2352x1568px; fundus photo — 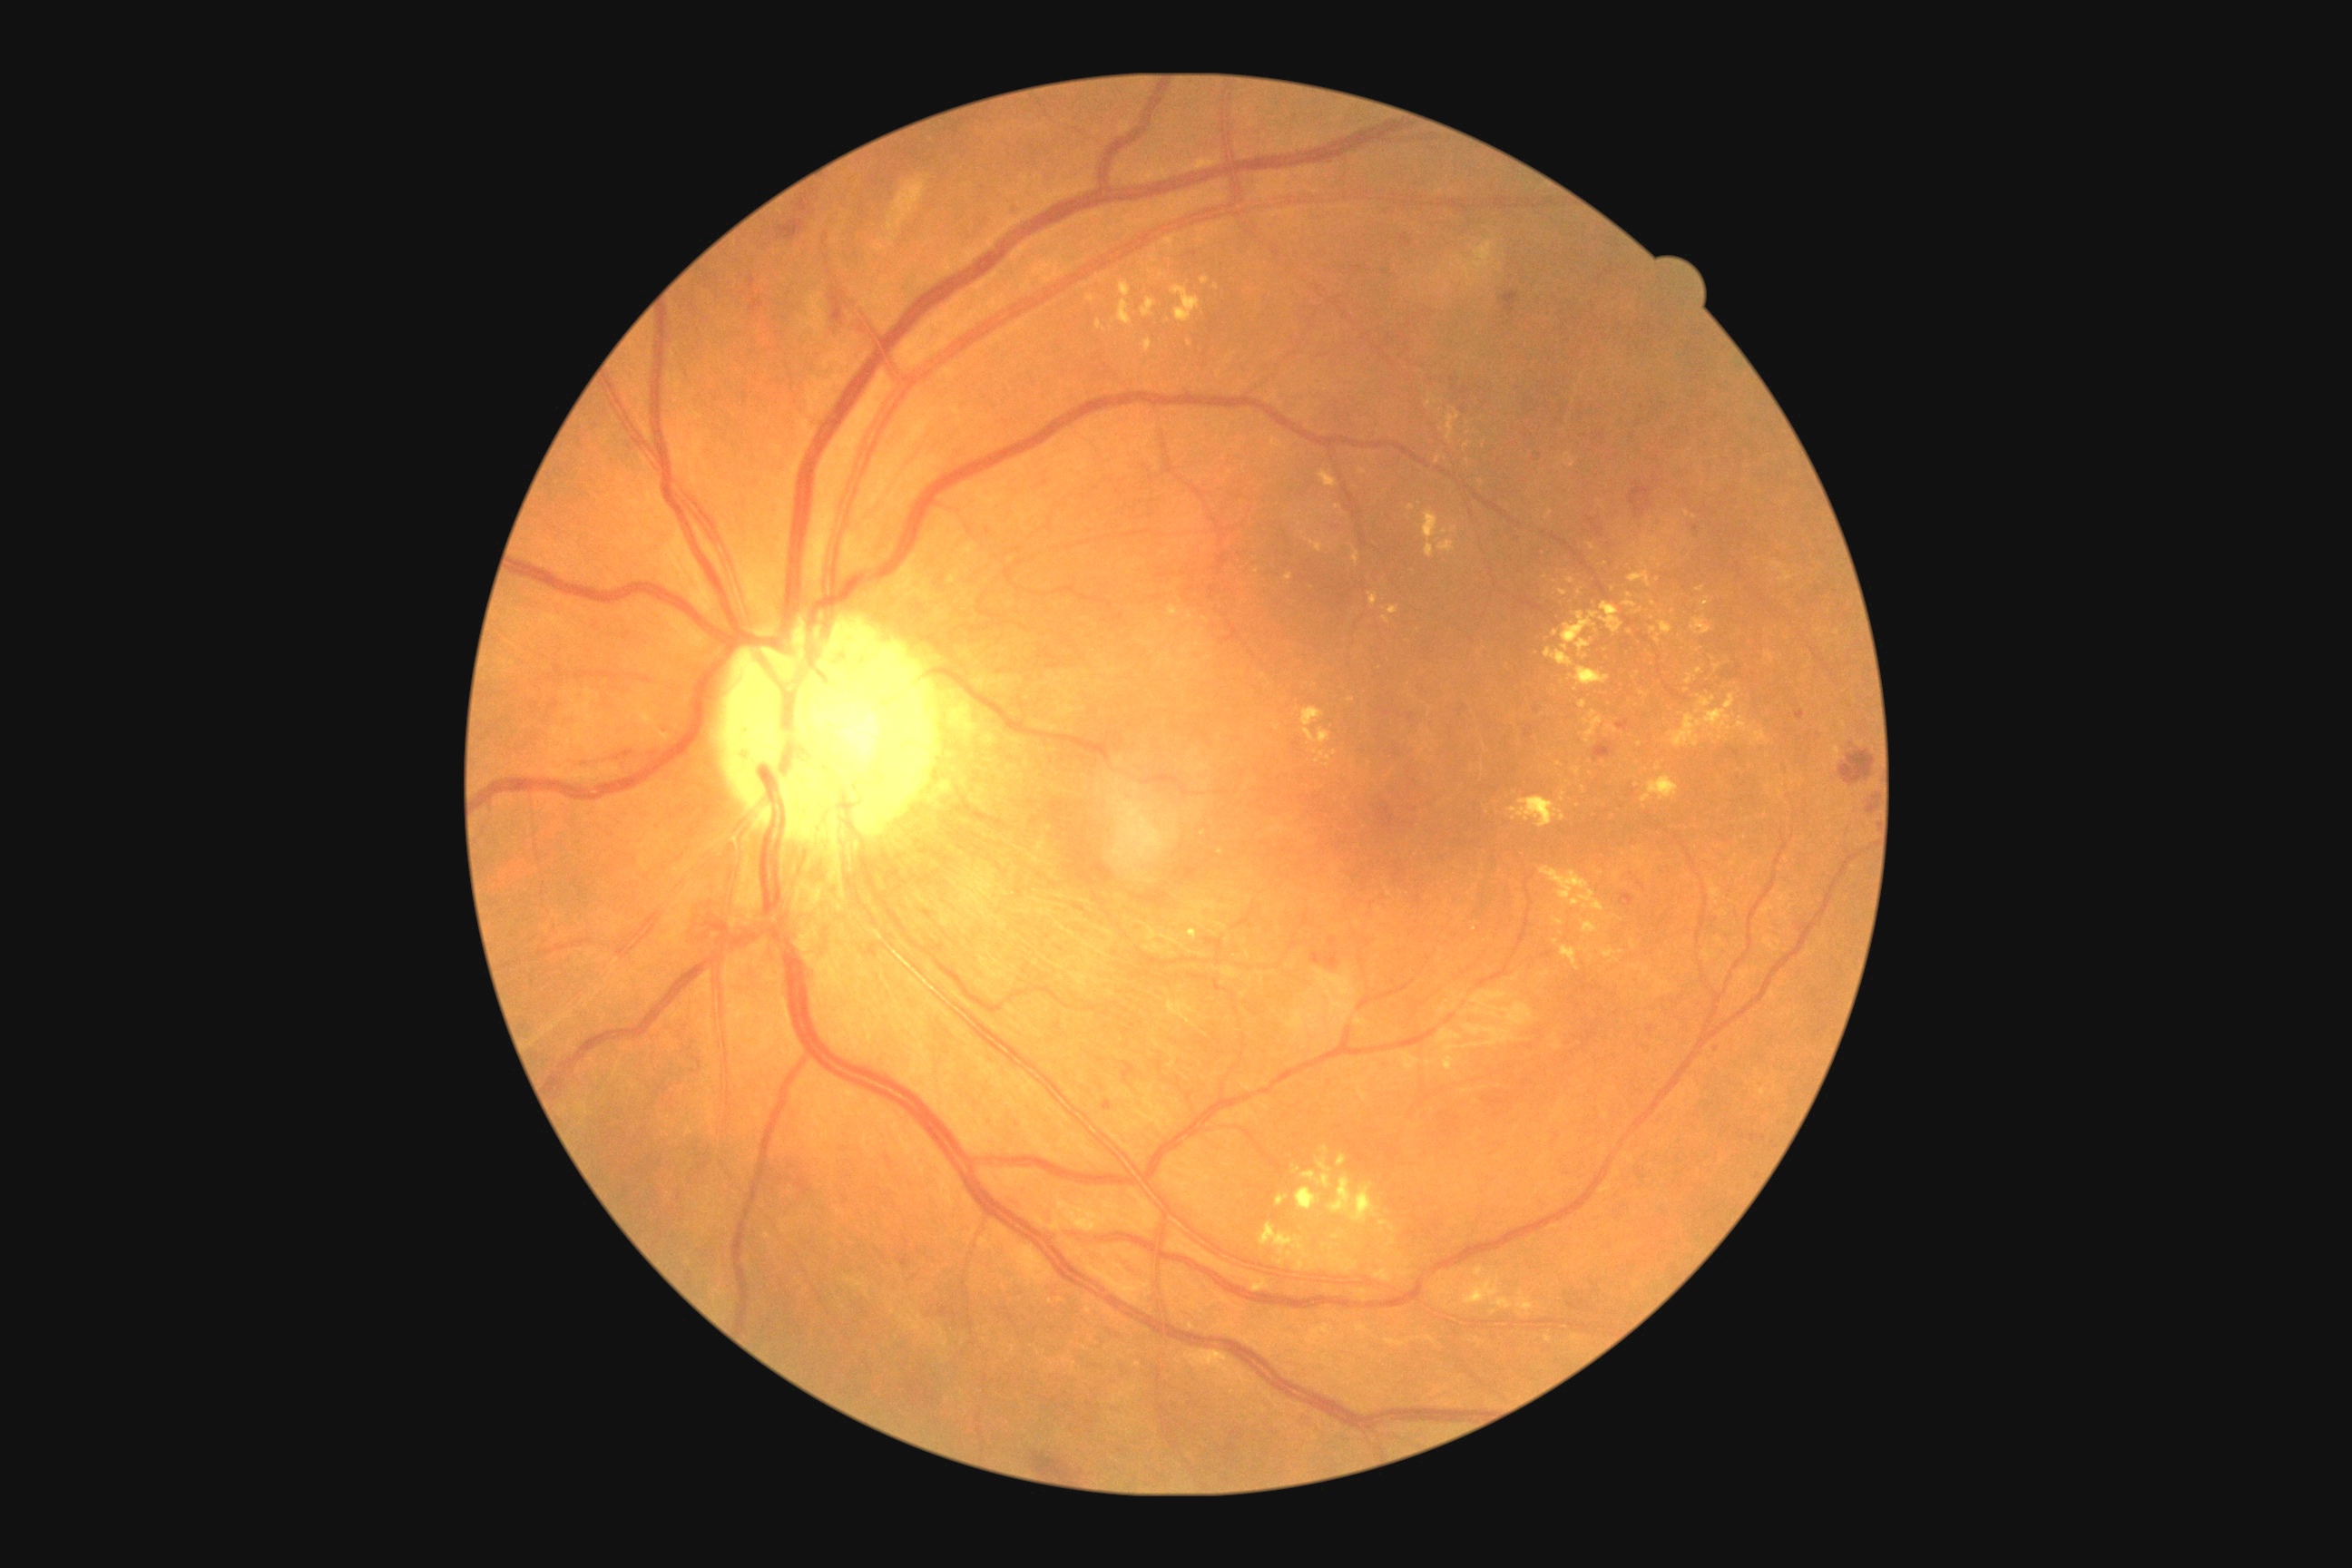
partial: true
dr_grade: 2
dr_grade_name: moderate NPDR
lesions:
  ex:
    - [x1=1444, y1=1057, x2=1455, y2=1070]
    - [x1=1351, y1=545, x2=1360, y2=567]
    - [x1=1142, y1=299, x2=1157, y2=317]
    - [x1=1389, y1=605, x2=1400, y2=614]
    - [x1=1117, y1=300, x2=1133, y2=326]
    - [x1=1088, y1=295, x2=1095, y2=304]
    - [x1=1600, y1=603, x2=1623, y2=634]
    - [x1=1407, y1=504, x2=1415, y2=511]
    - [x1=1587, y1=544, x2=1596, y2=551]
    - [x1=1701, y1=598, x2=1710, y2=607]
    - [x1=1509, y1=798, x2=1565, y2=828]
  ex_small_centers:
    - 1559/765
    - 1658/552
    - 1385/620
    - 1100/279
    - 1630/596
    - 1717/668
    - 1438/542
    - 1555/633